1240 by 1240 pixels. Pediatric wide-field fundus photograph.
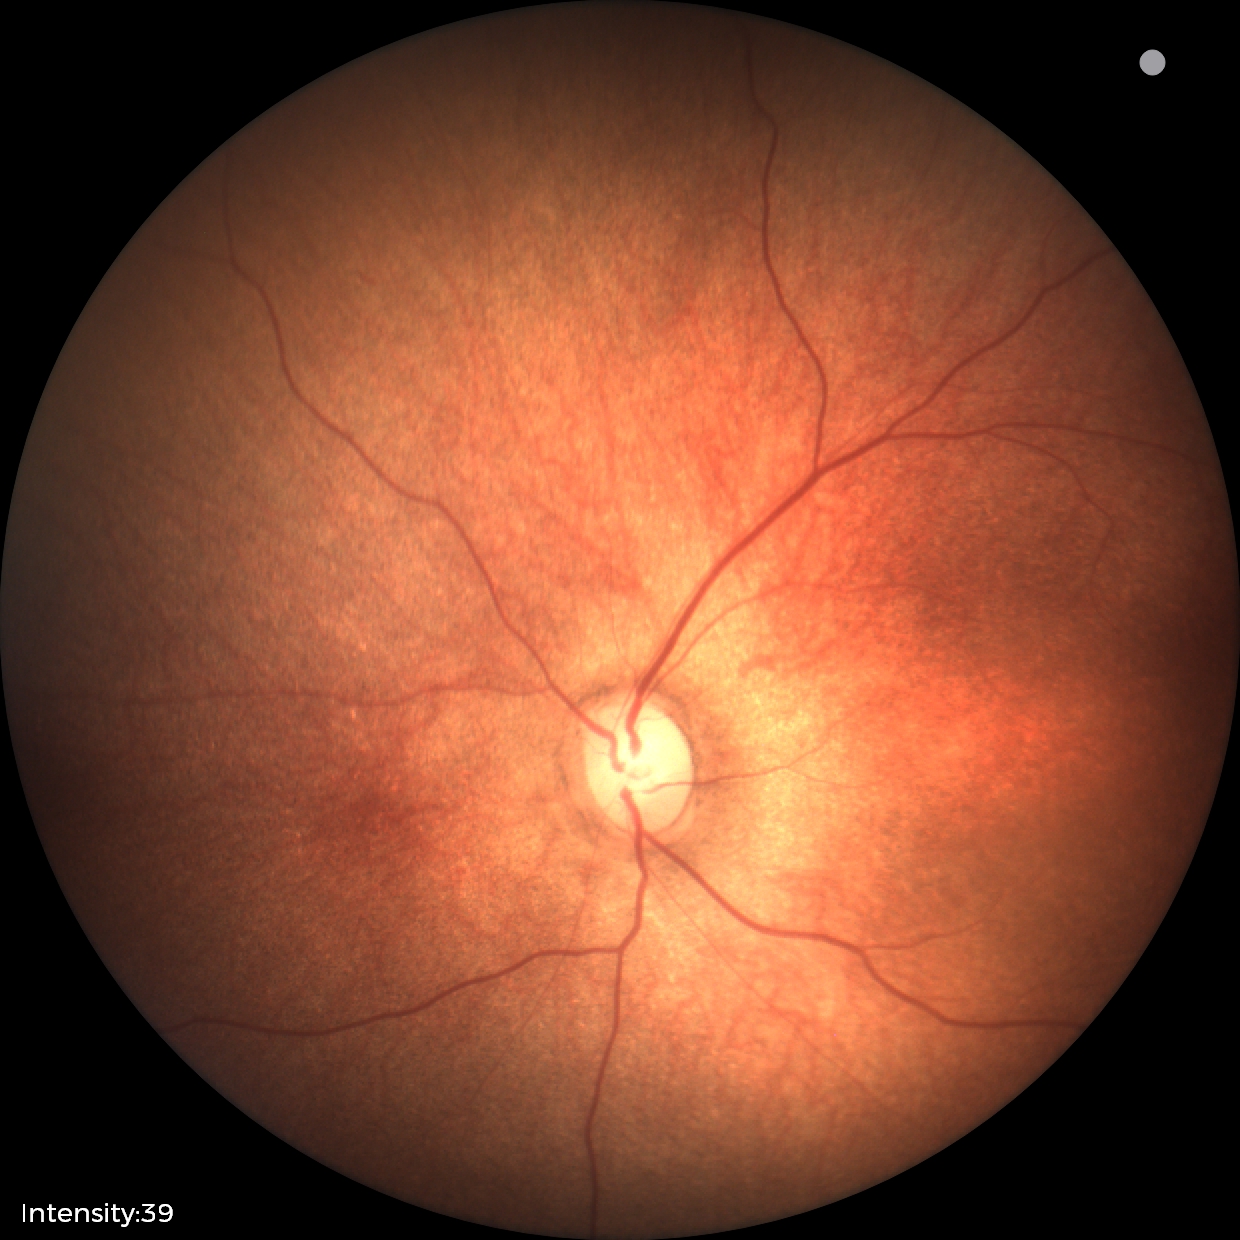

Q: What was the screening finding?
A: physiological appearance with no retinal pathology